2212 by 1659 pixels, 45° FOV — 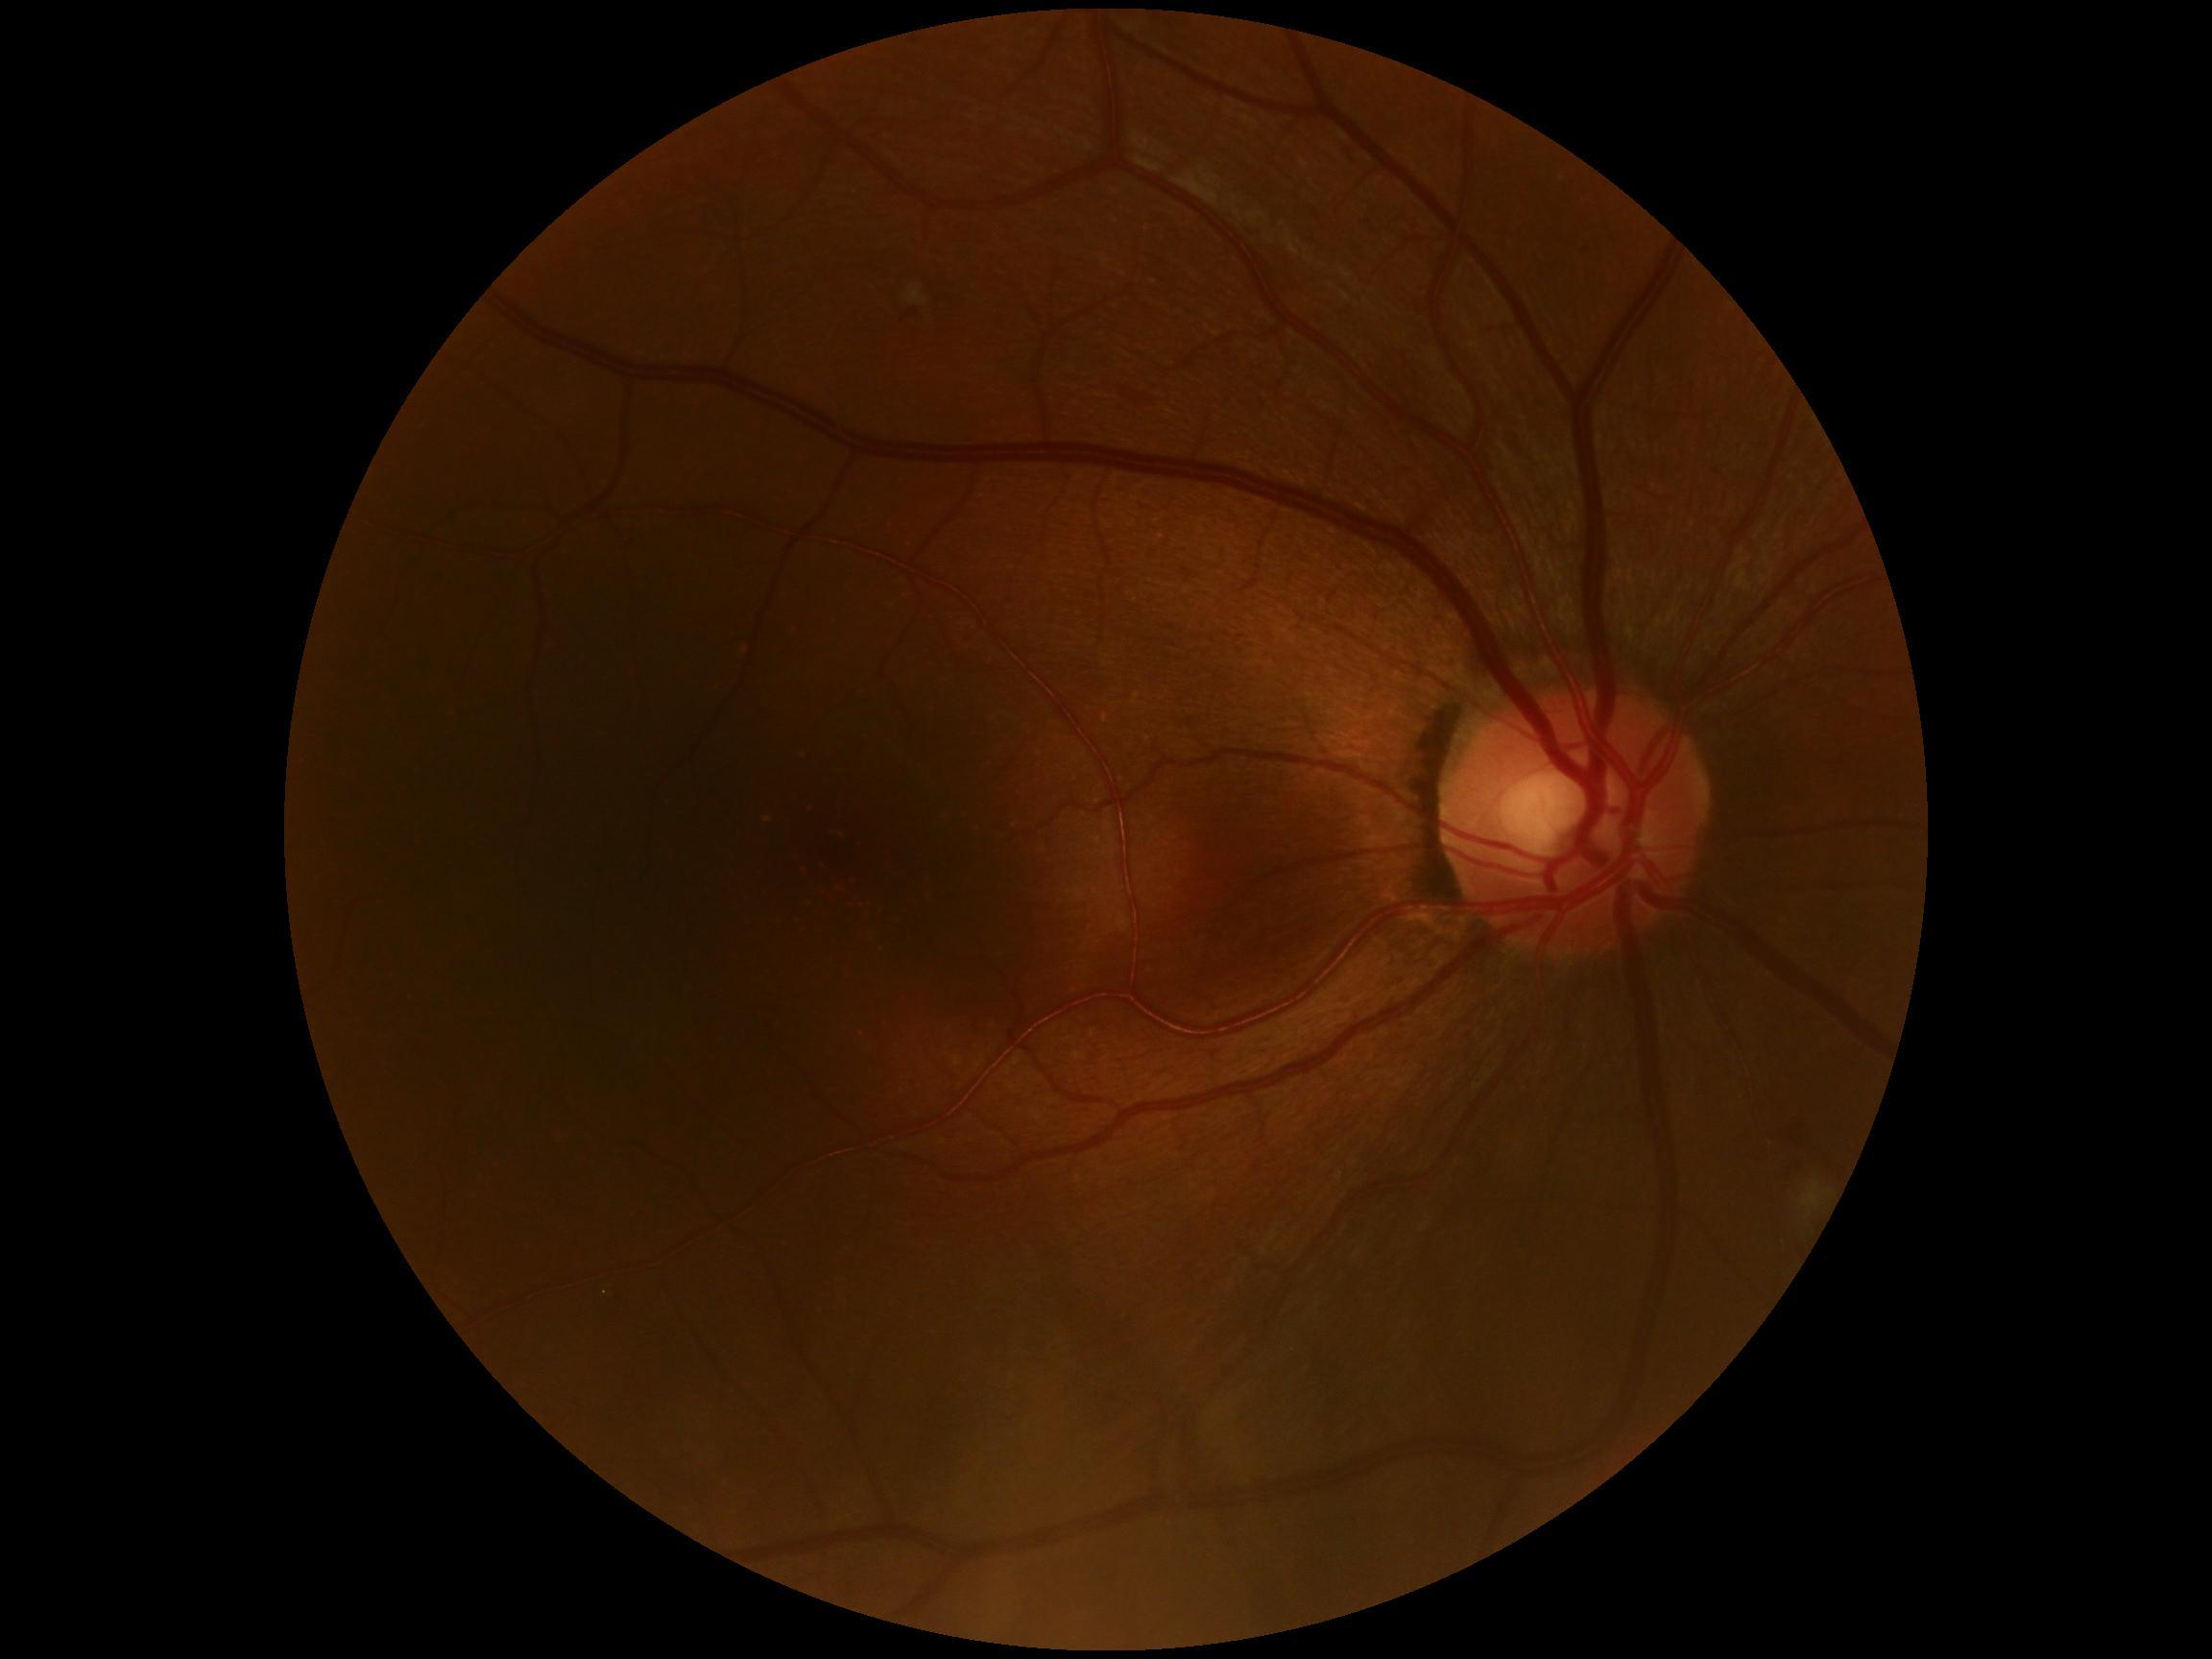 retinopathy@2.